Acquired with a NIDEK AFC-230 · FOV: 45 degrees · 848 x 848 pixels · nonmydriatic.
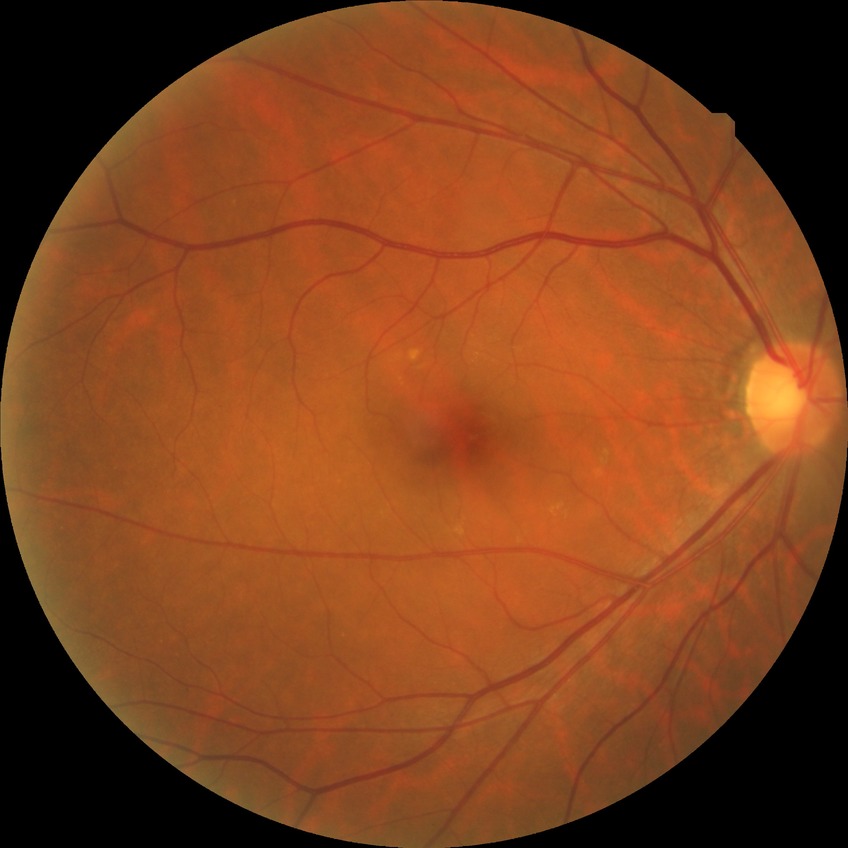 Diabetic retinopathy (DR): no diabetic retinopathy (NDR).